Modified Davis classification.
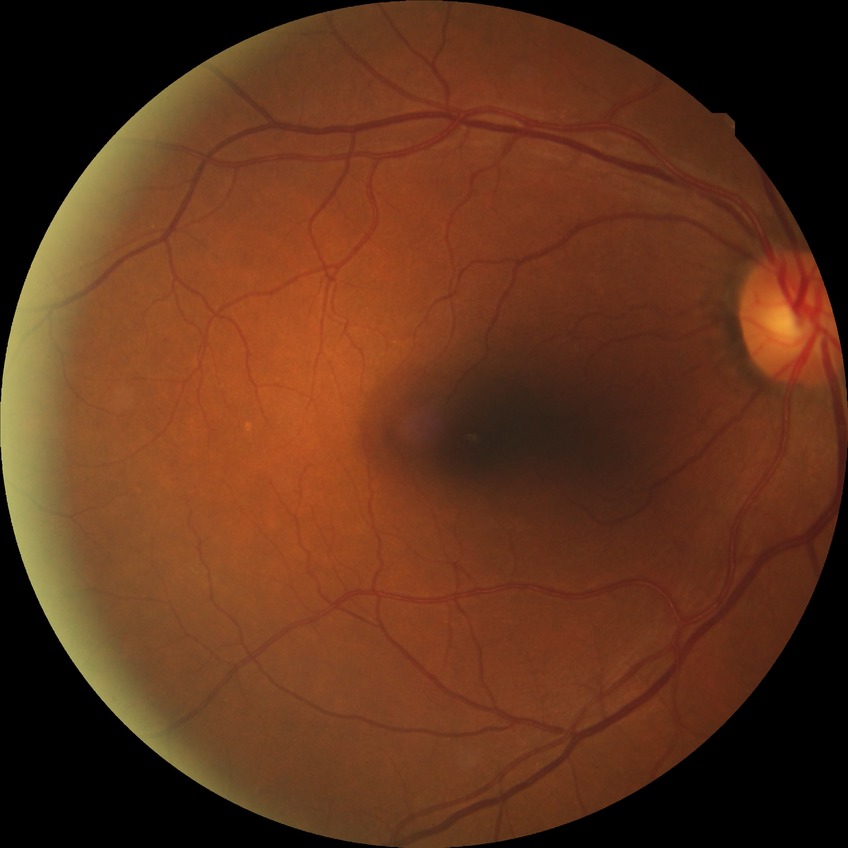
diabetic retinopathy stage: simple diabetic retinopathy